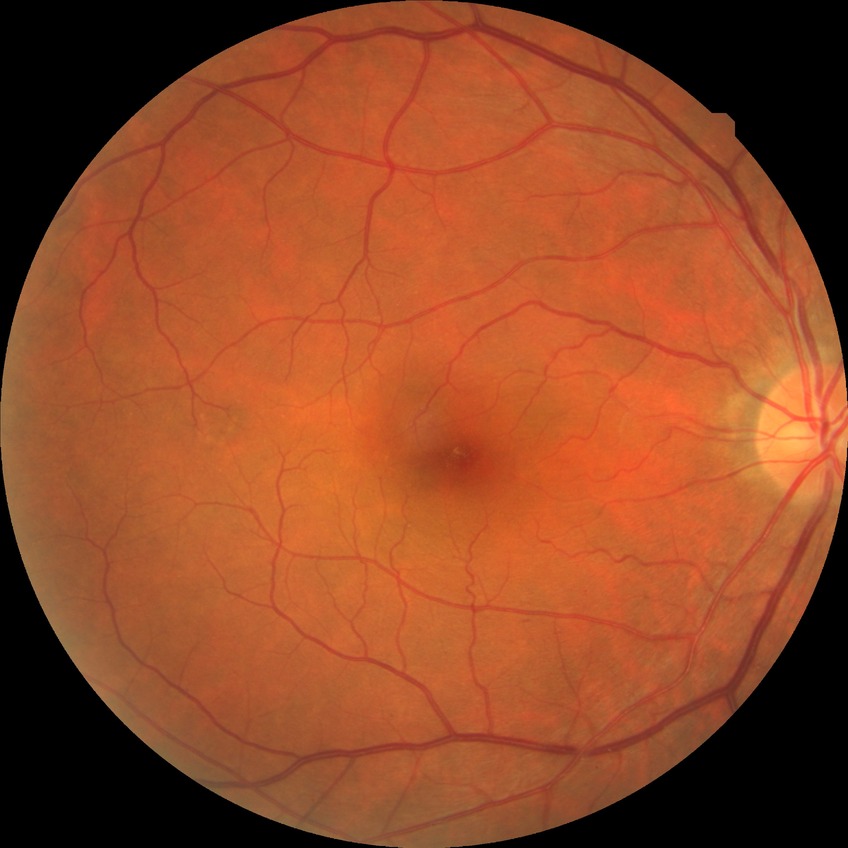 Diabetic retinopathy (DR) is NDR (no diabetic retinopathy).